UWF retinal mosaic
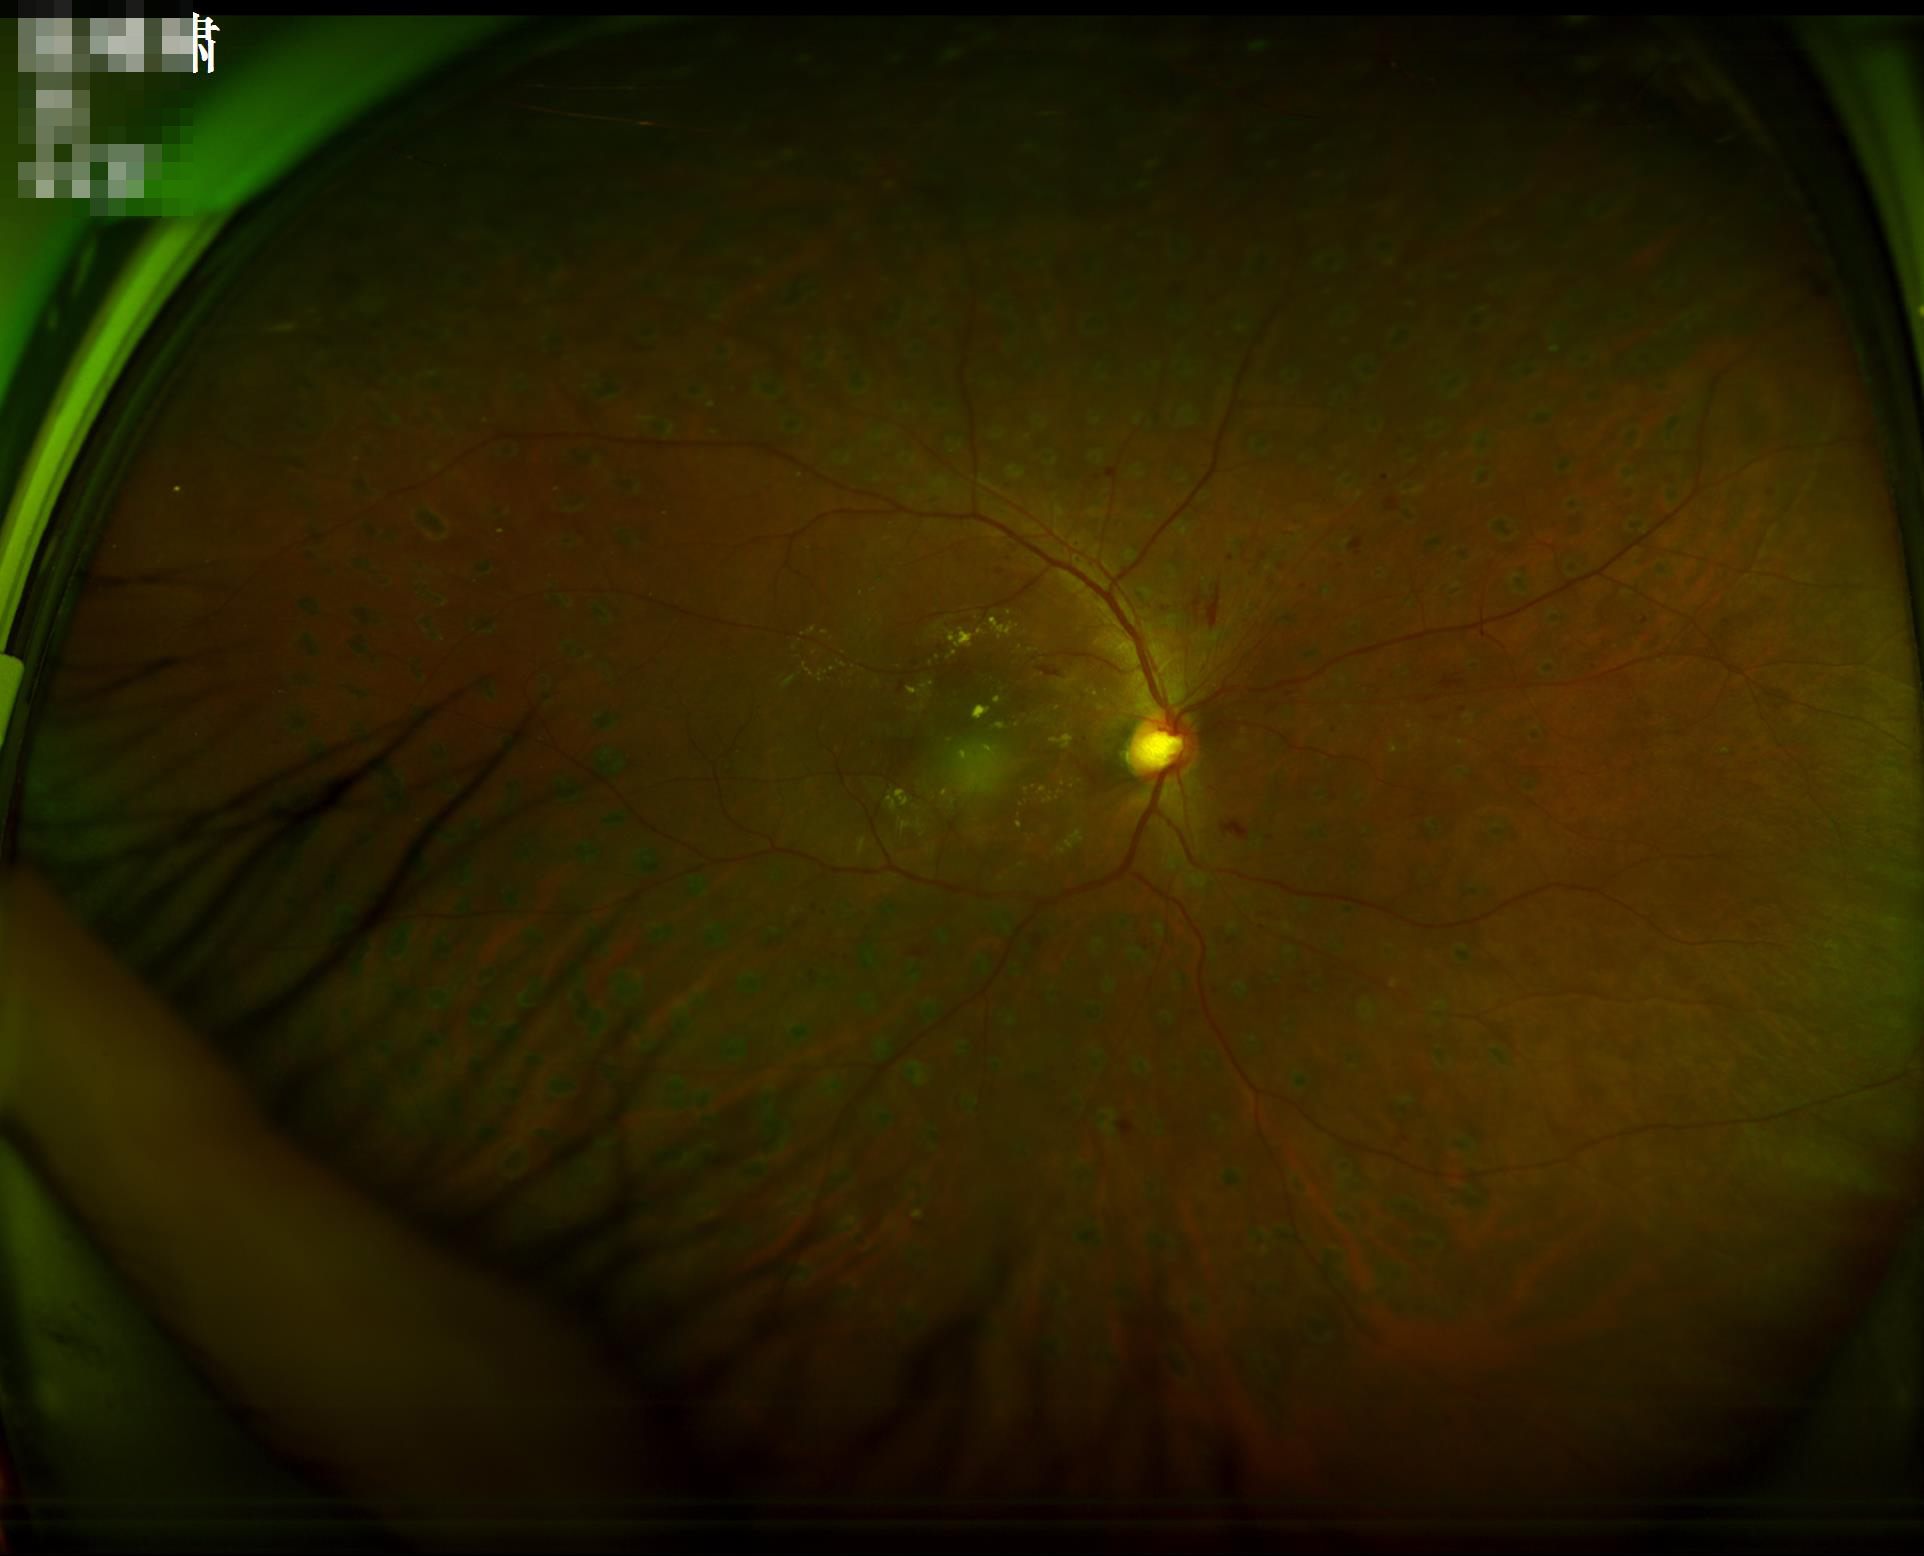
Good dynamic range. Overall image quality is good.